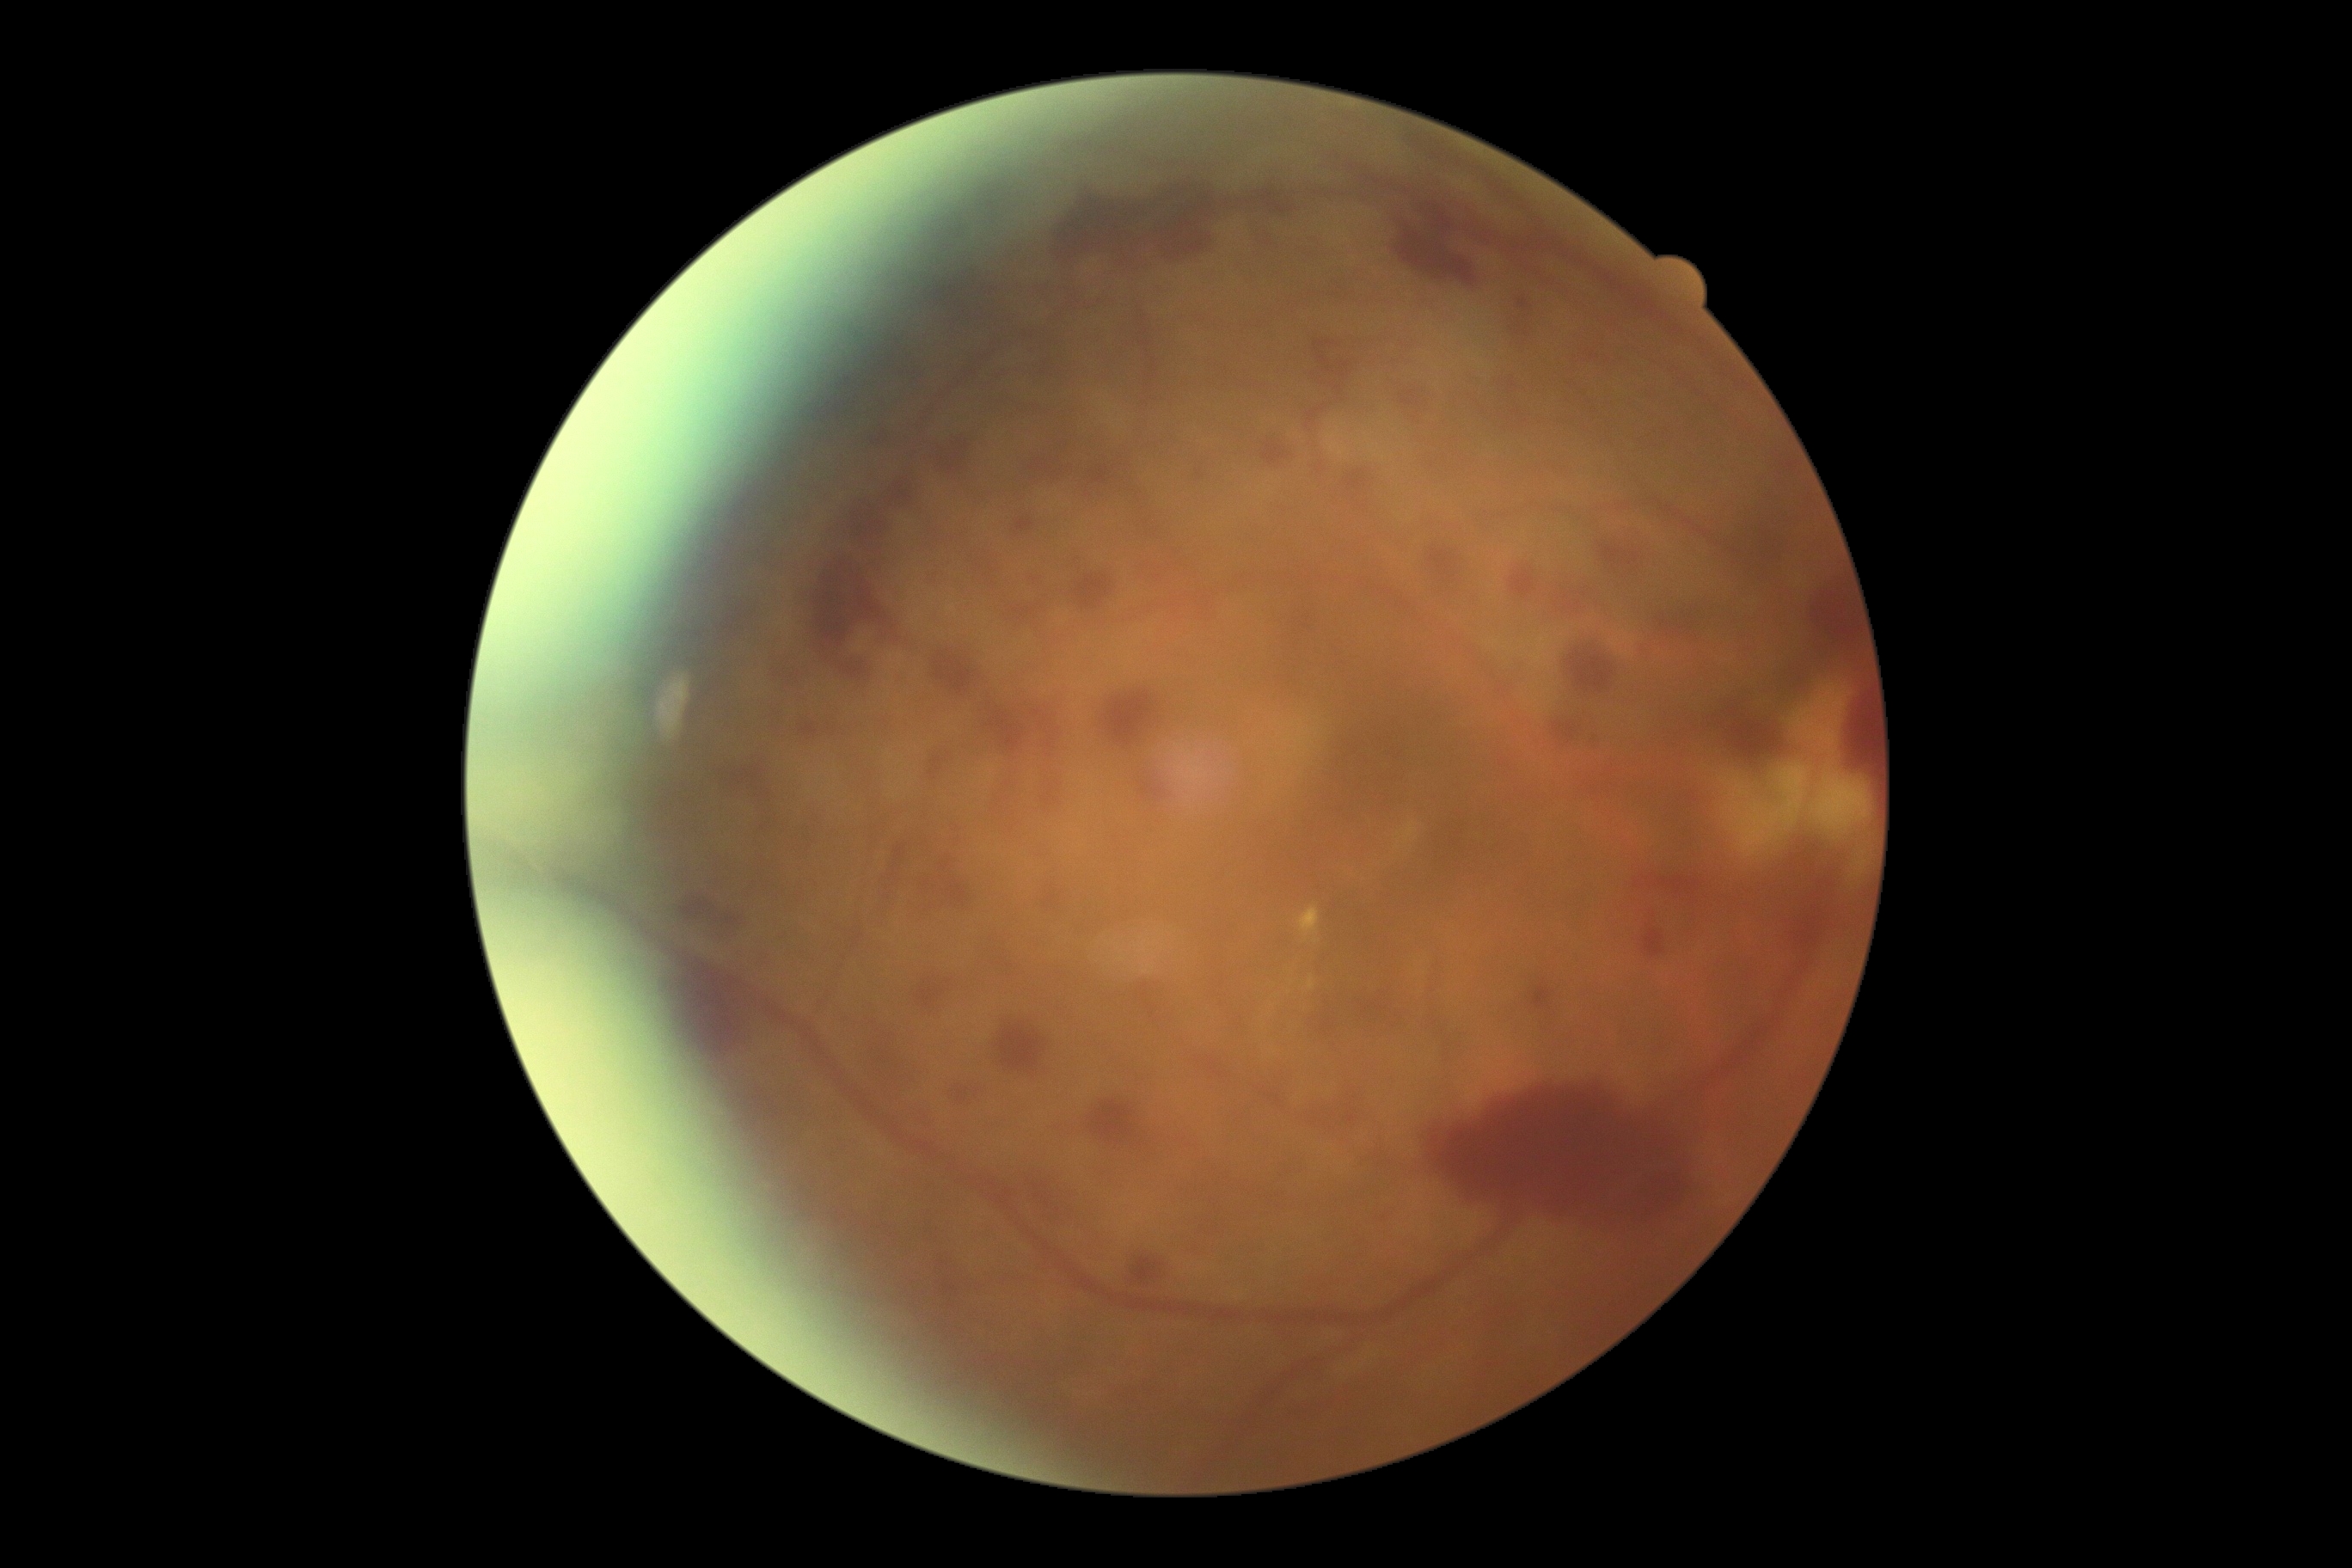
DR stage: PDR (grade 4).